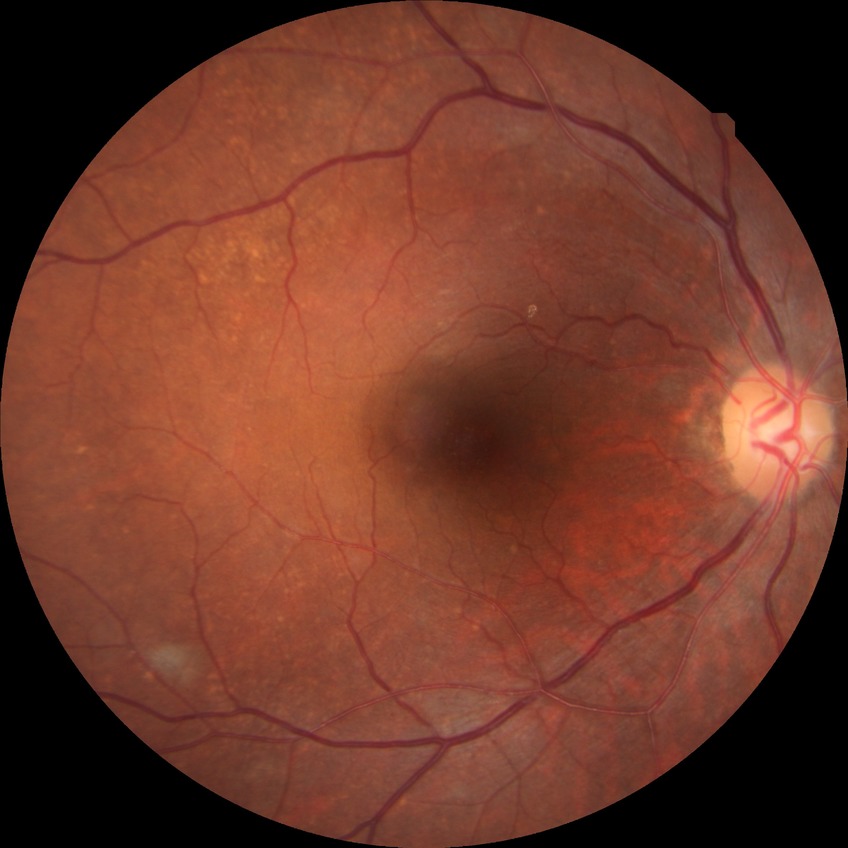
Davis stage: NDR.